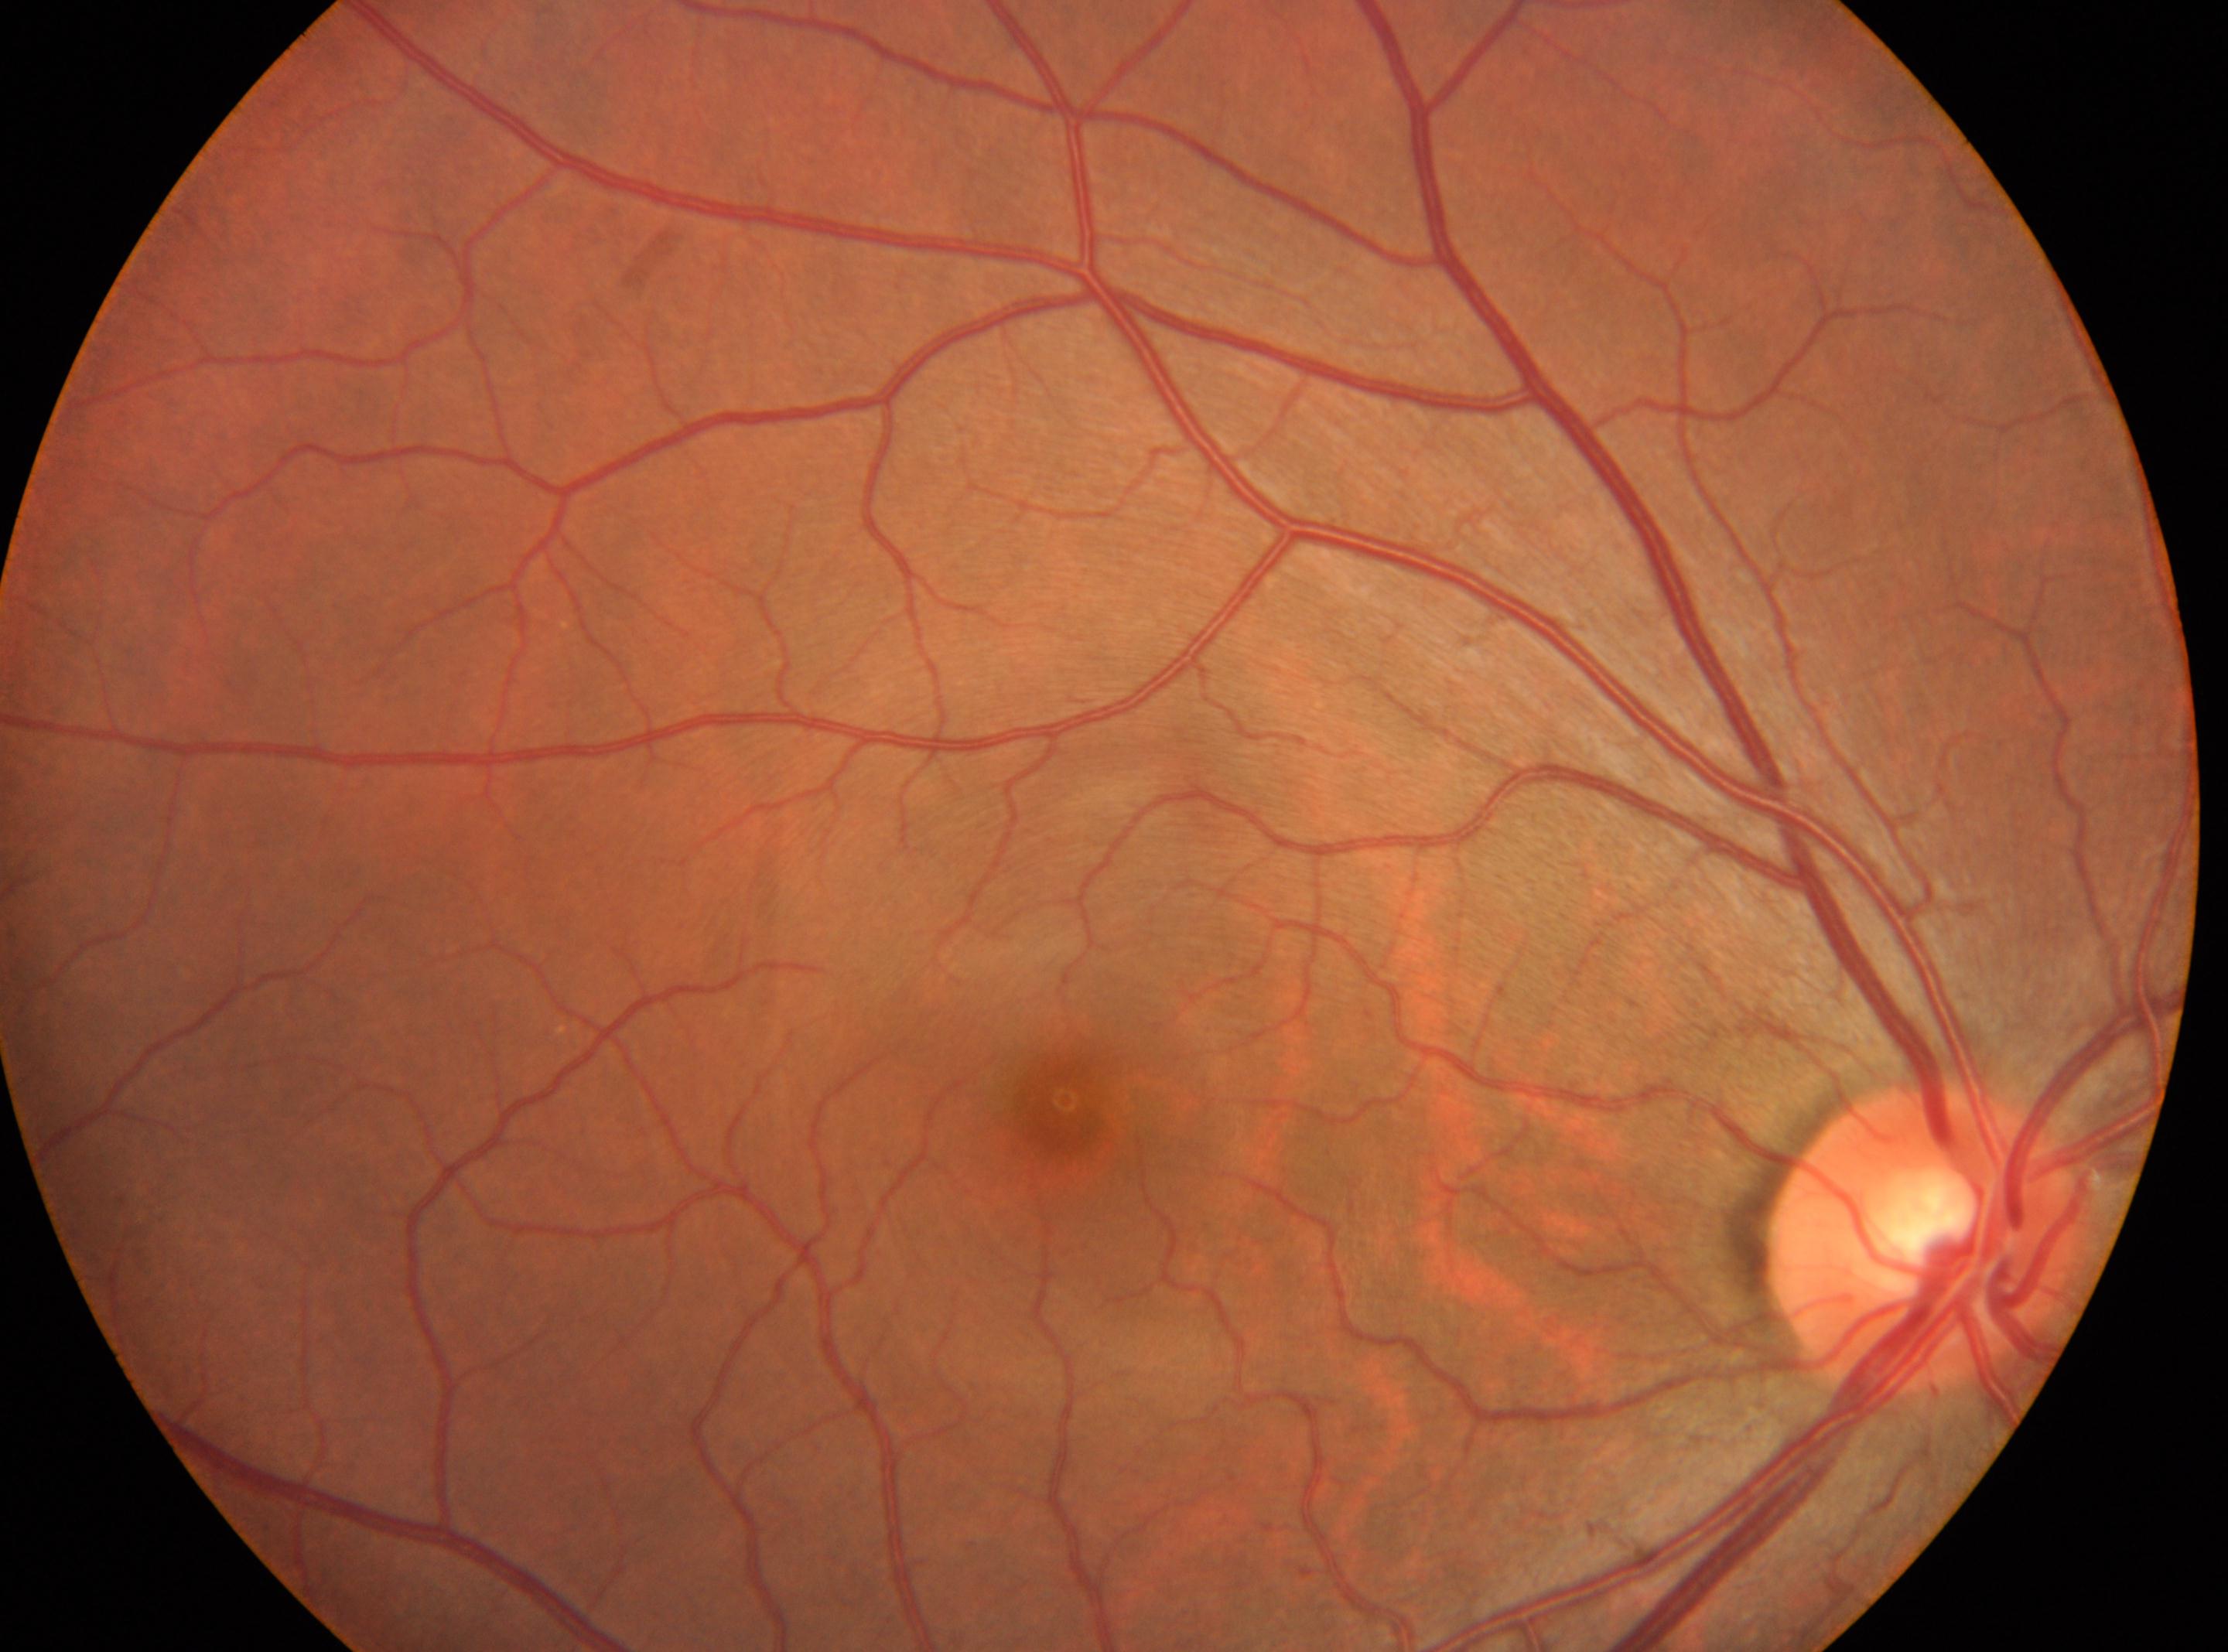 {"eye": "oculus dexter", "optic_disc": "[1922, 1237]", "dr_grade": "0 (no apparent retinopathy)", "fovea": "[1064, 1108]", "dr_impression": "No DR findings"}